Wide-field contact fundus photograph of an infant · captured with the Clarity RetCam 3 (130° field of view) — 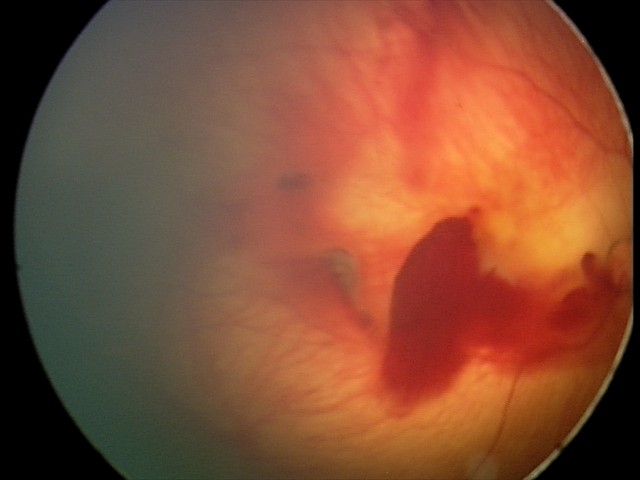 Screening examination consistent with retinal hemorrhages.